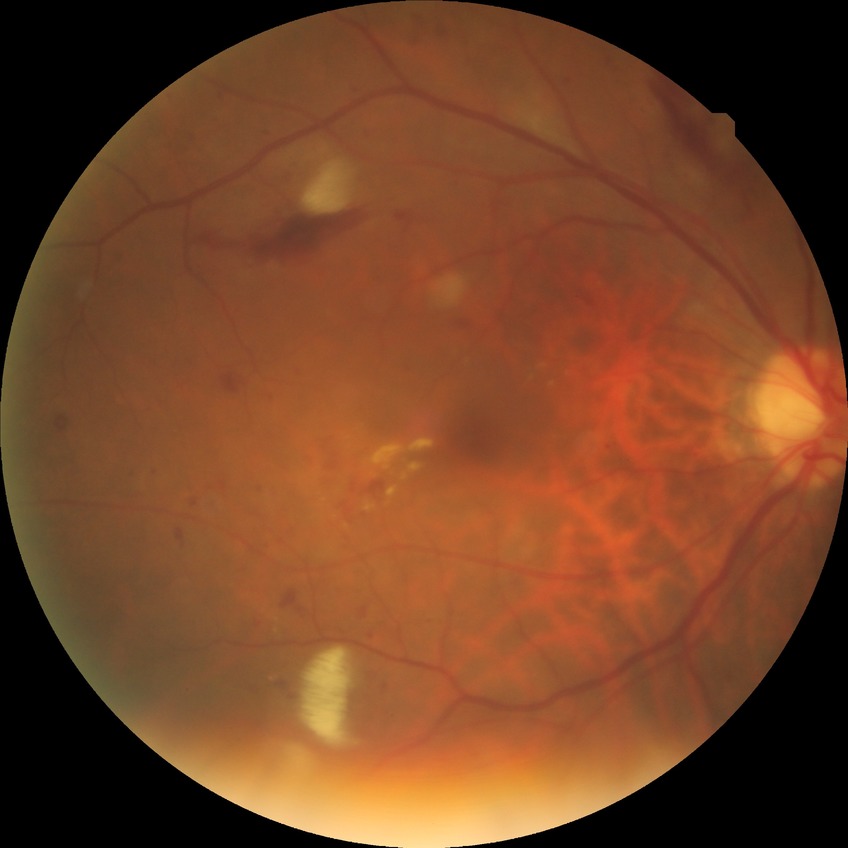 Modified Davis grade is PPDR.